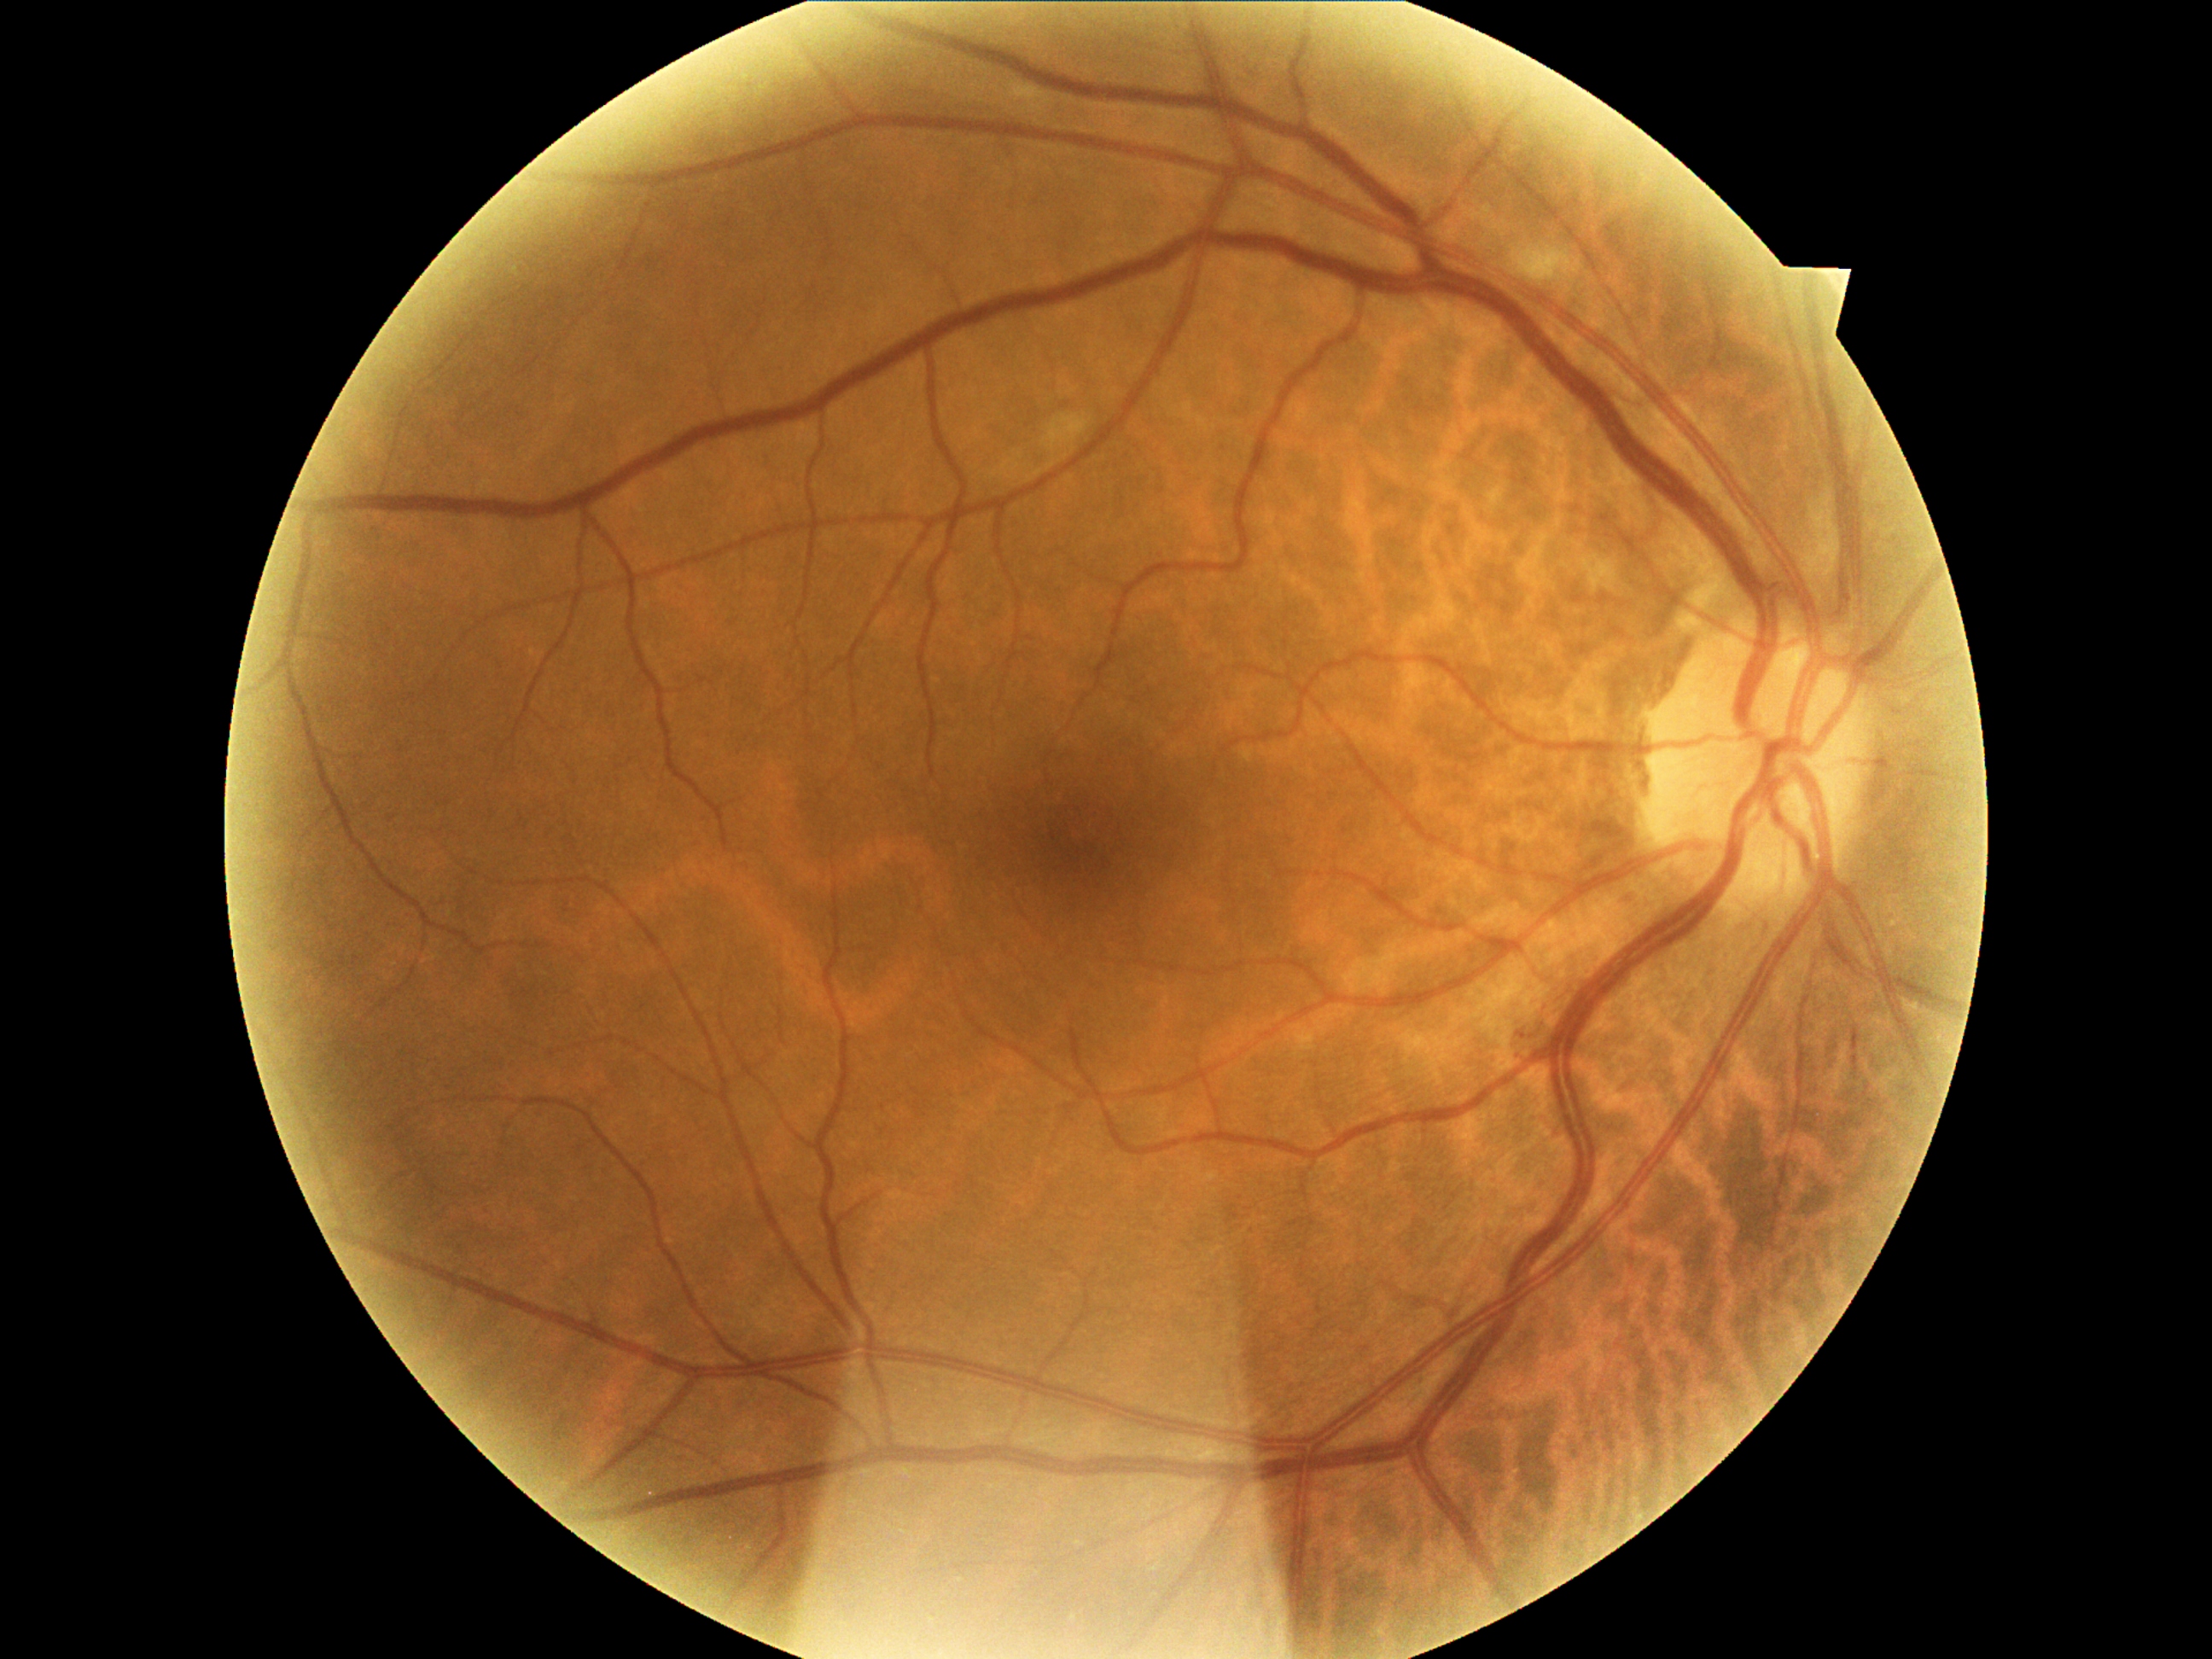
DR class: non-proliferative diabetic retinopathy. DR: moderate NPDR (grade 2).